2352x1568px: 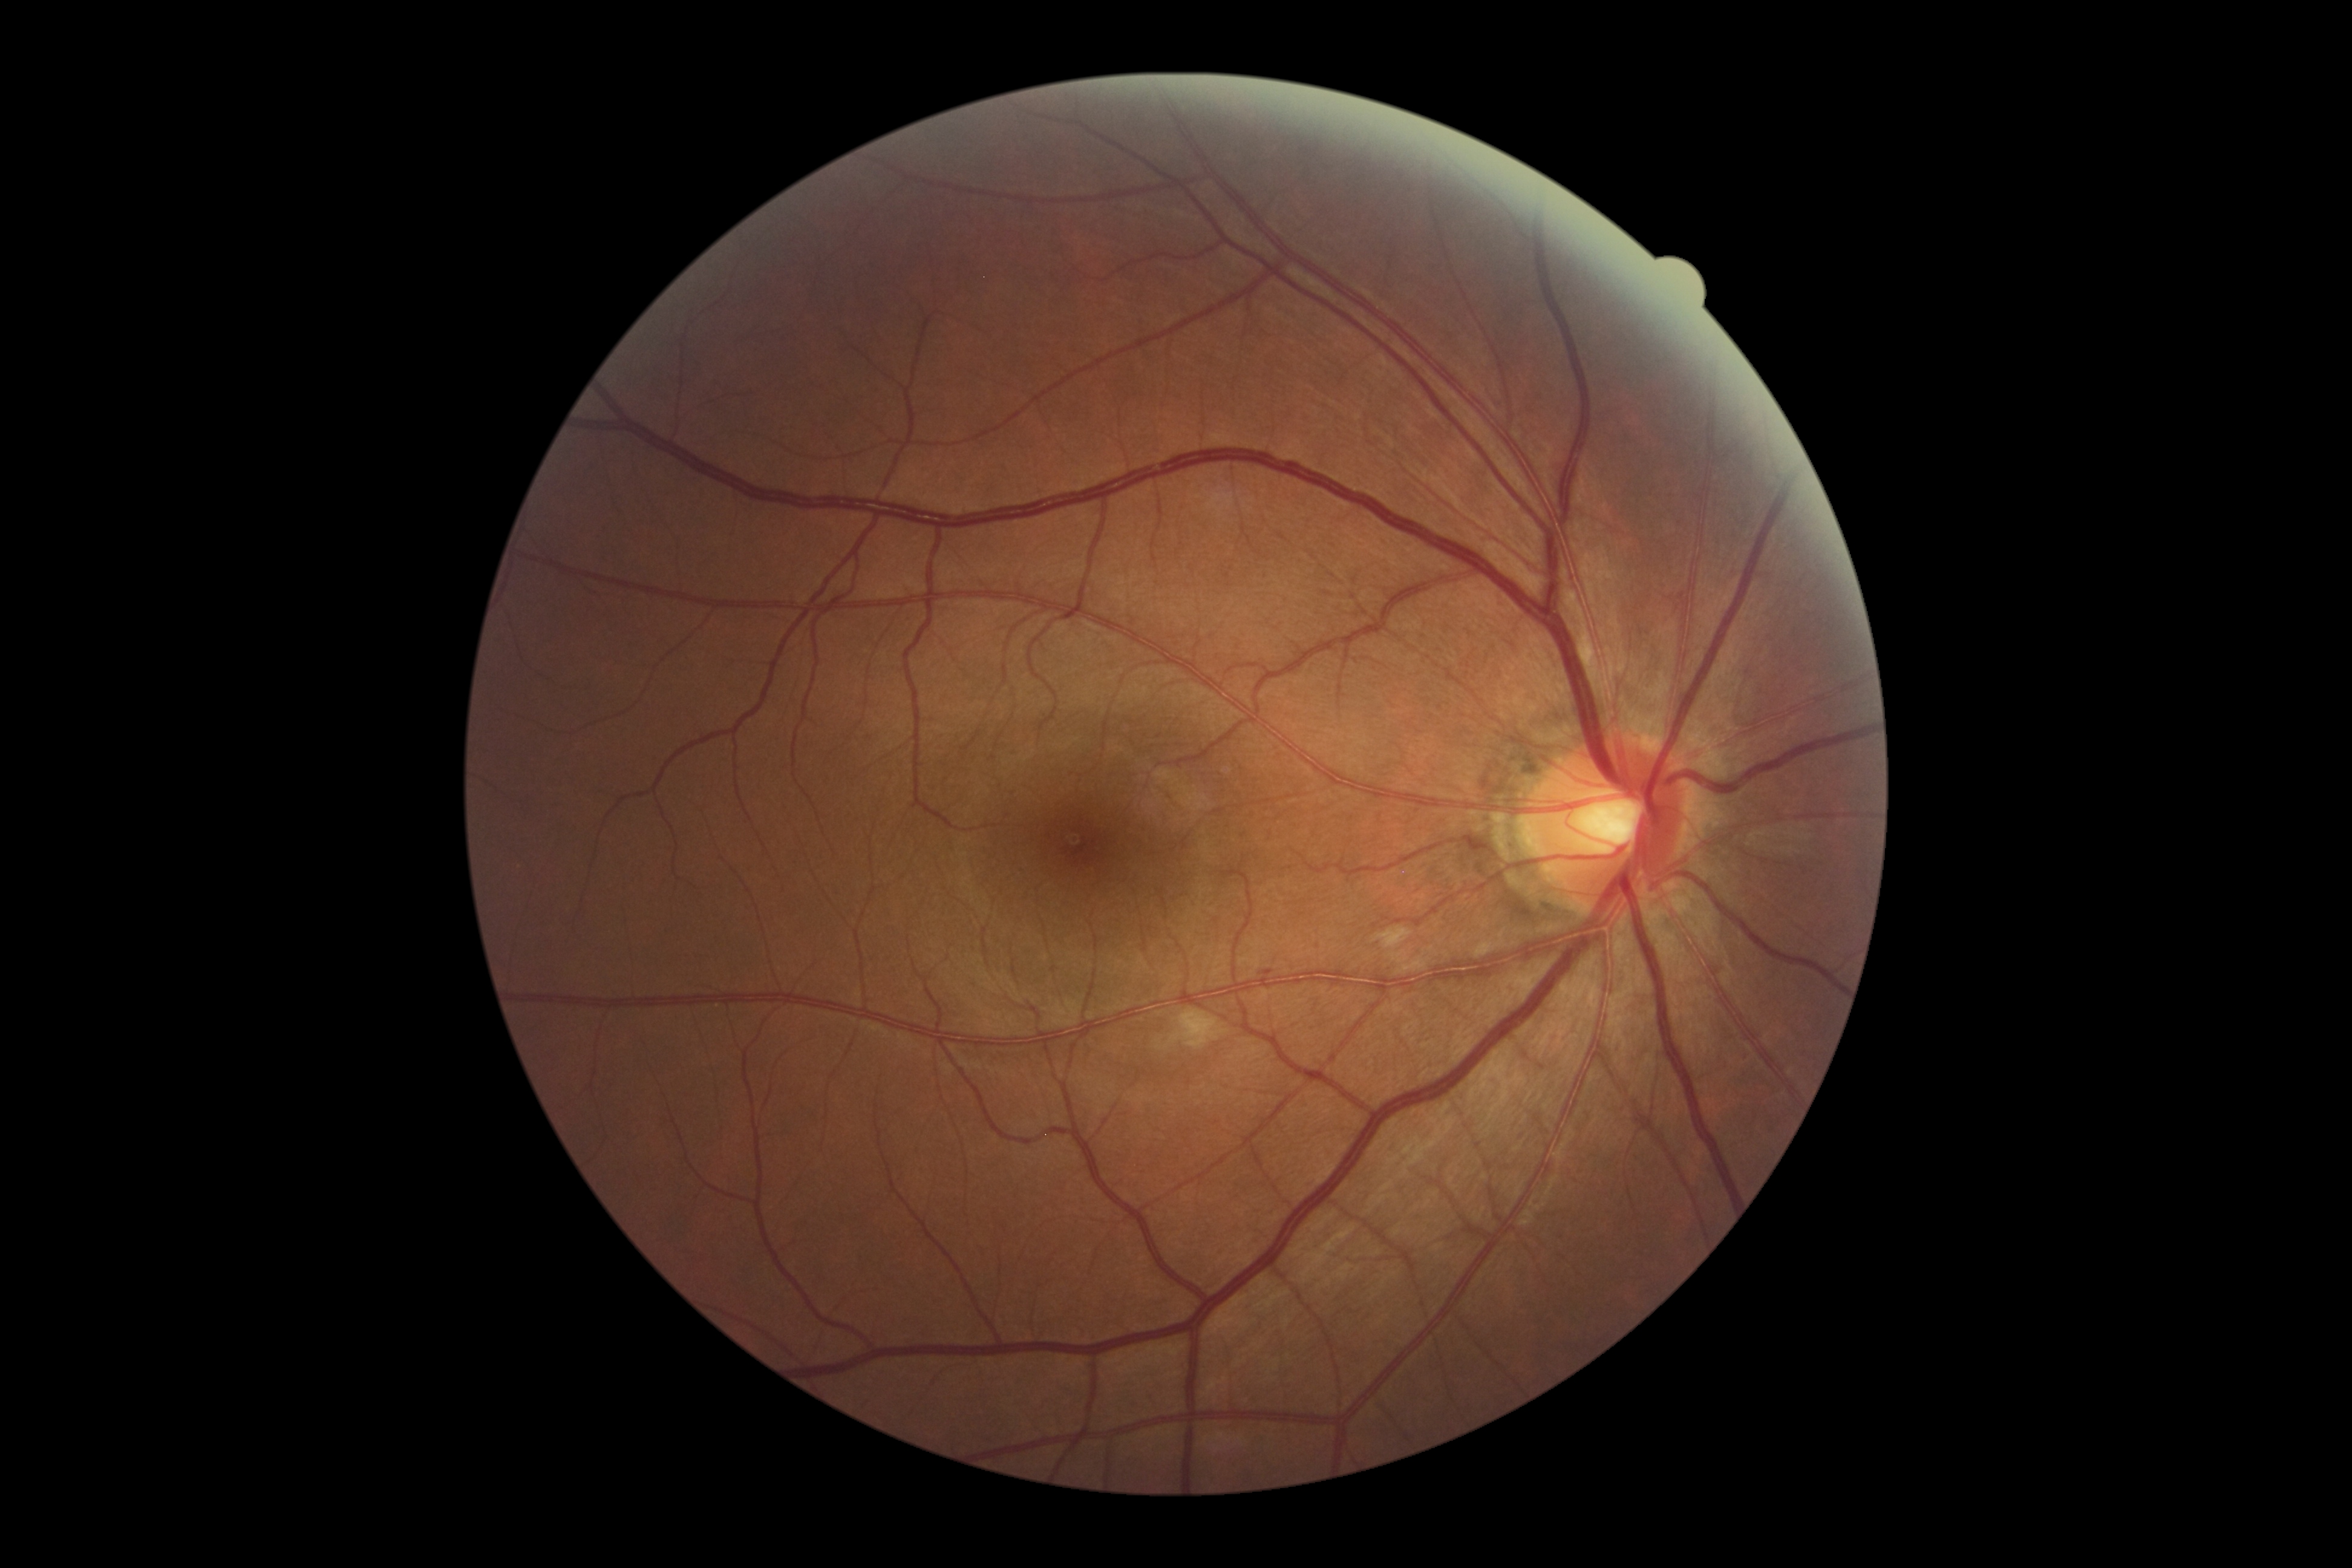

DR severity is moderate non-proliferative diabetic retinopathy (grade 2).